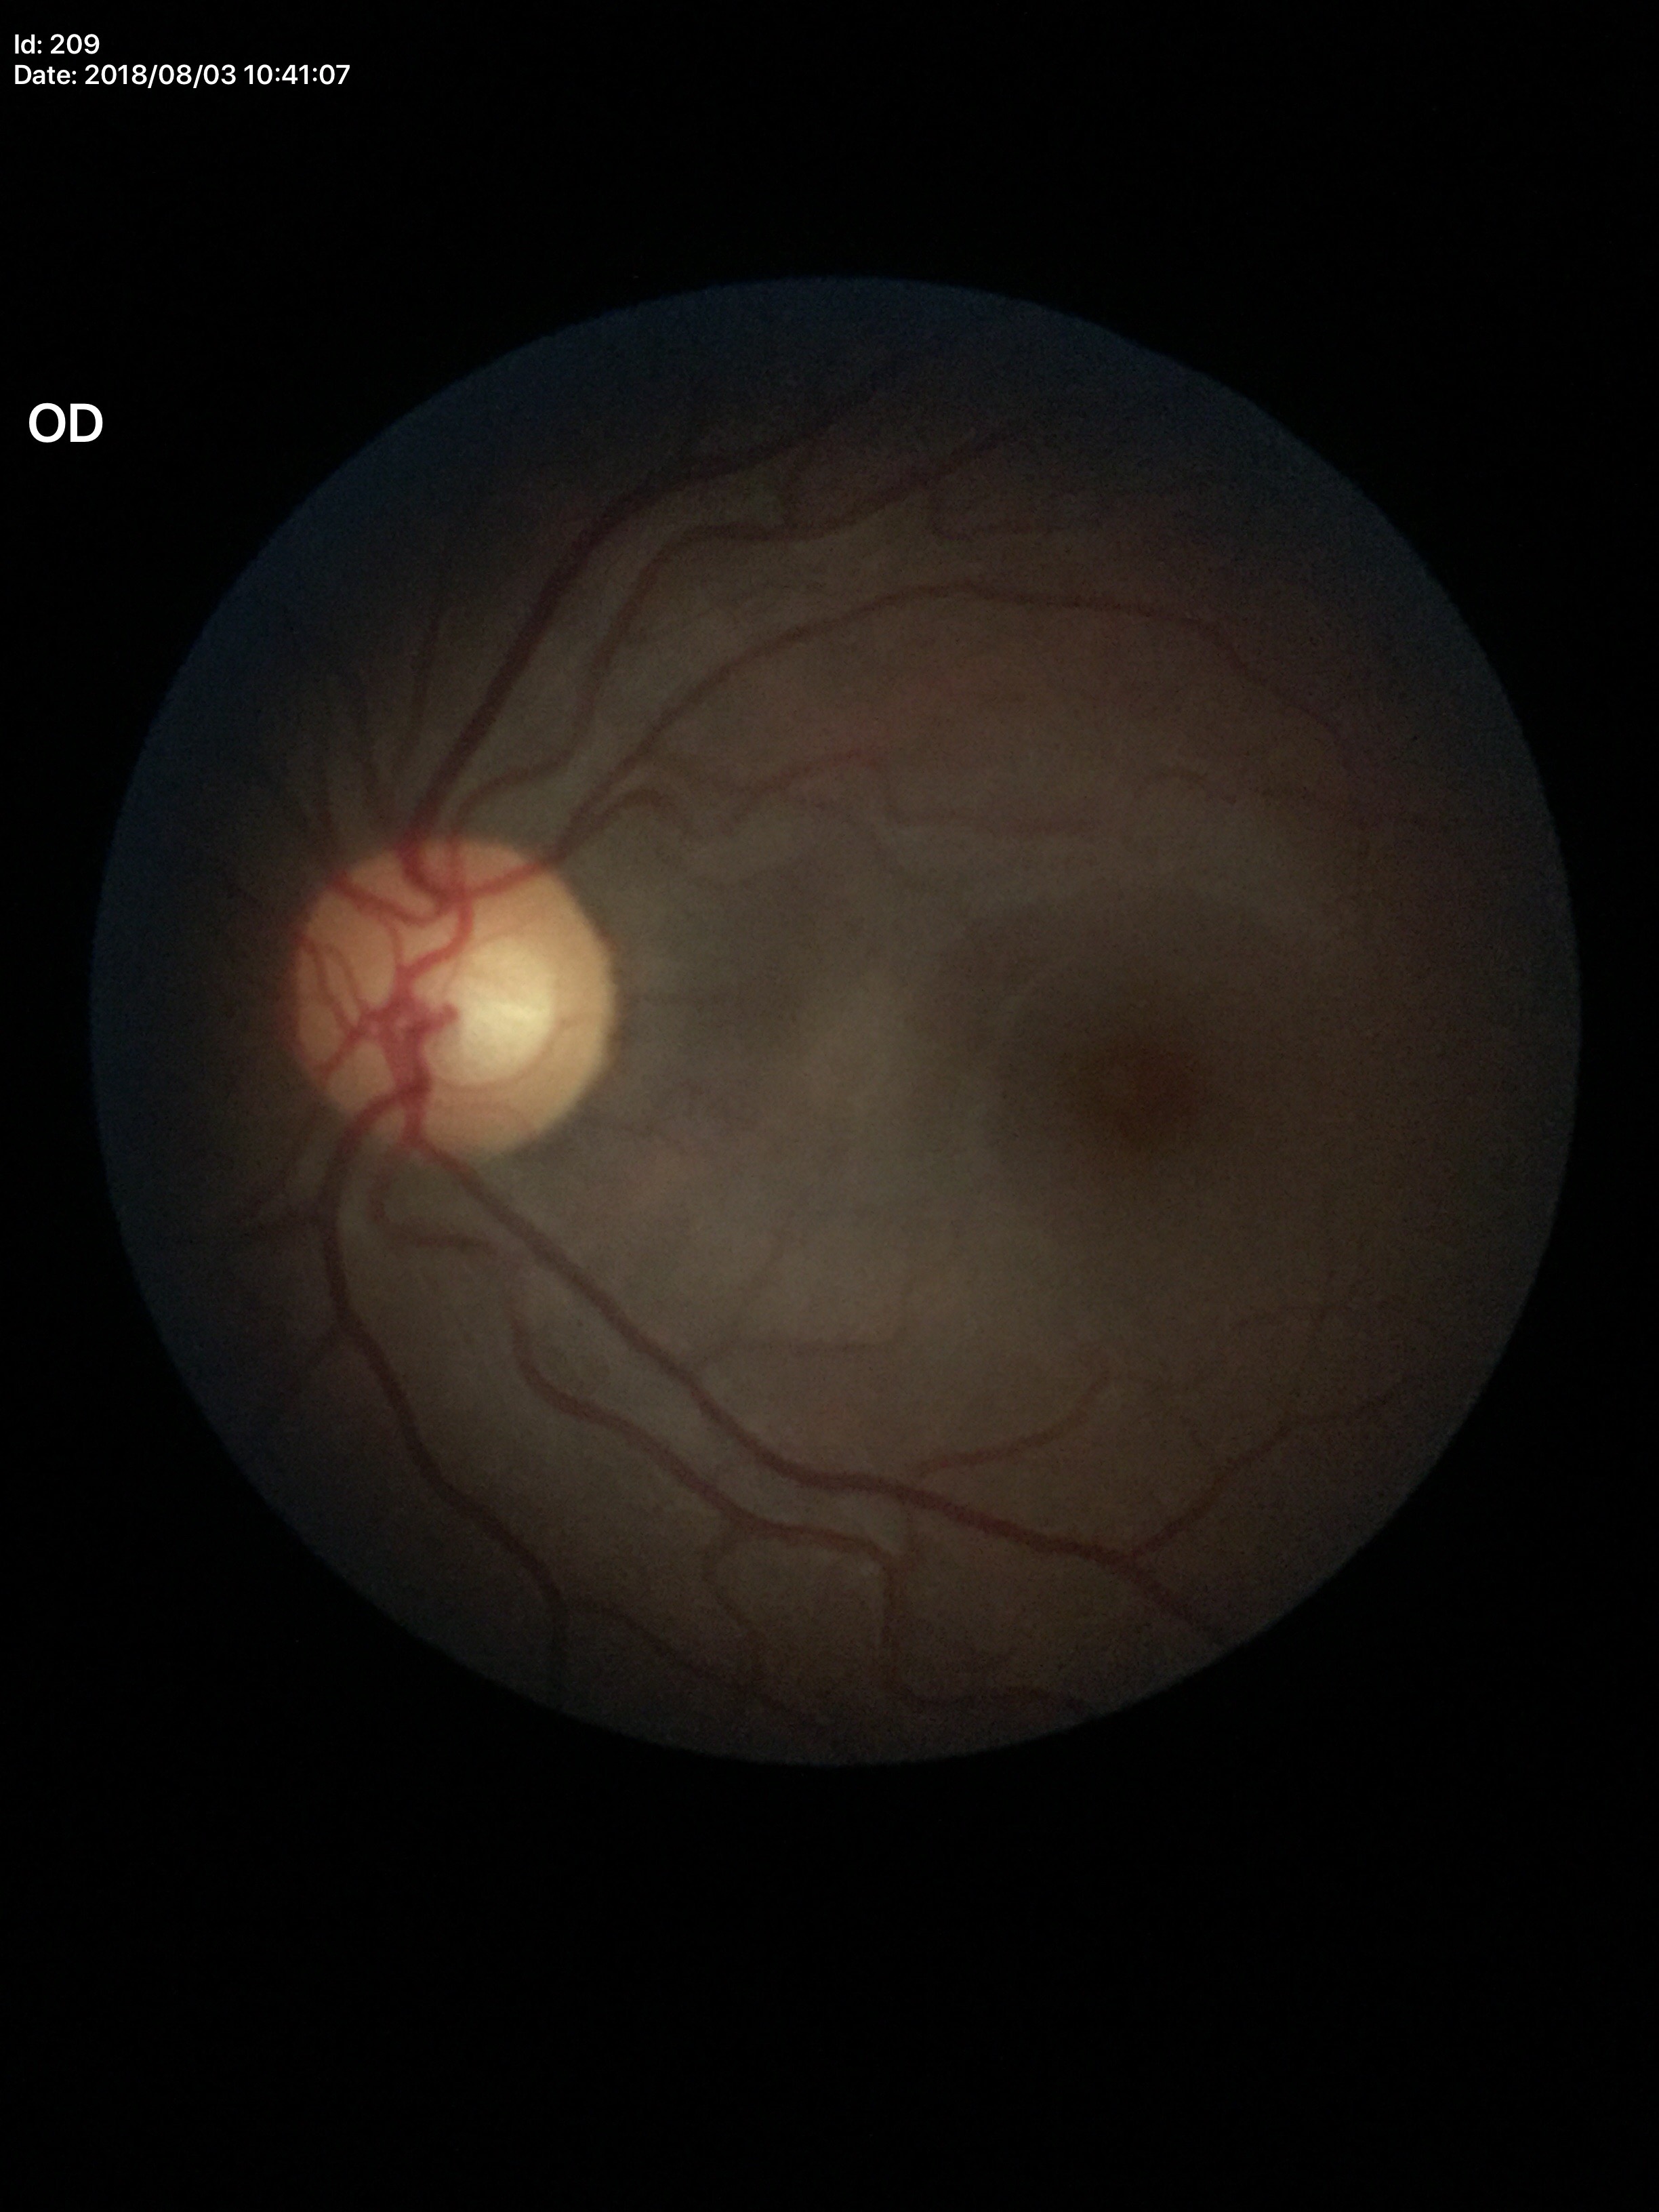 Glaucoma impression: not suspect, vertical C/D ratio (VCDR): 0.47, horizontal CDR (HCDR): 0.53.